Color fundus photograph · 45° field of view · 2048 by 1536 pixels
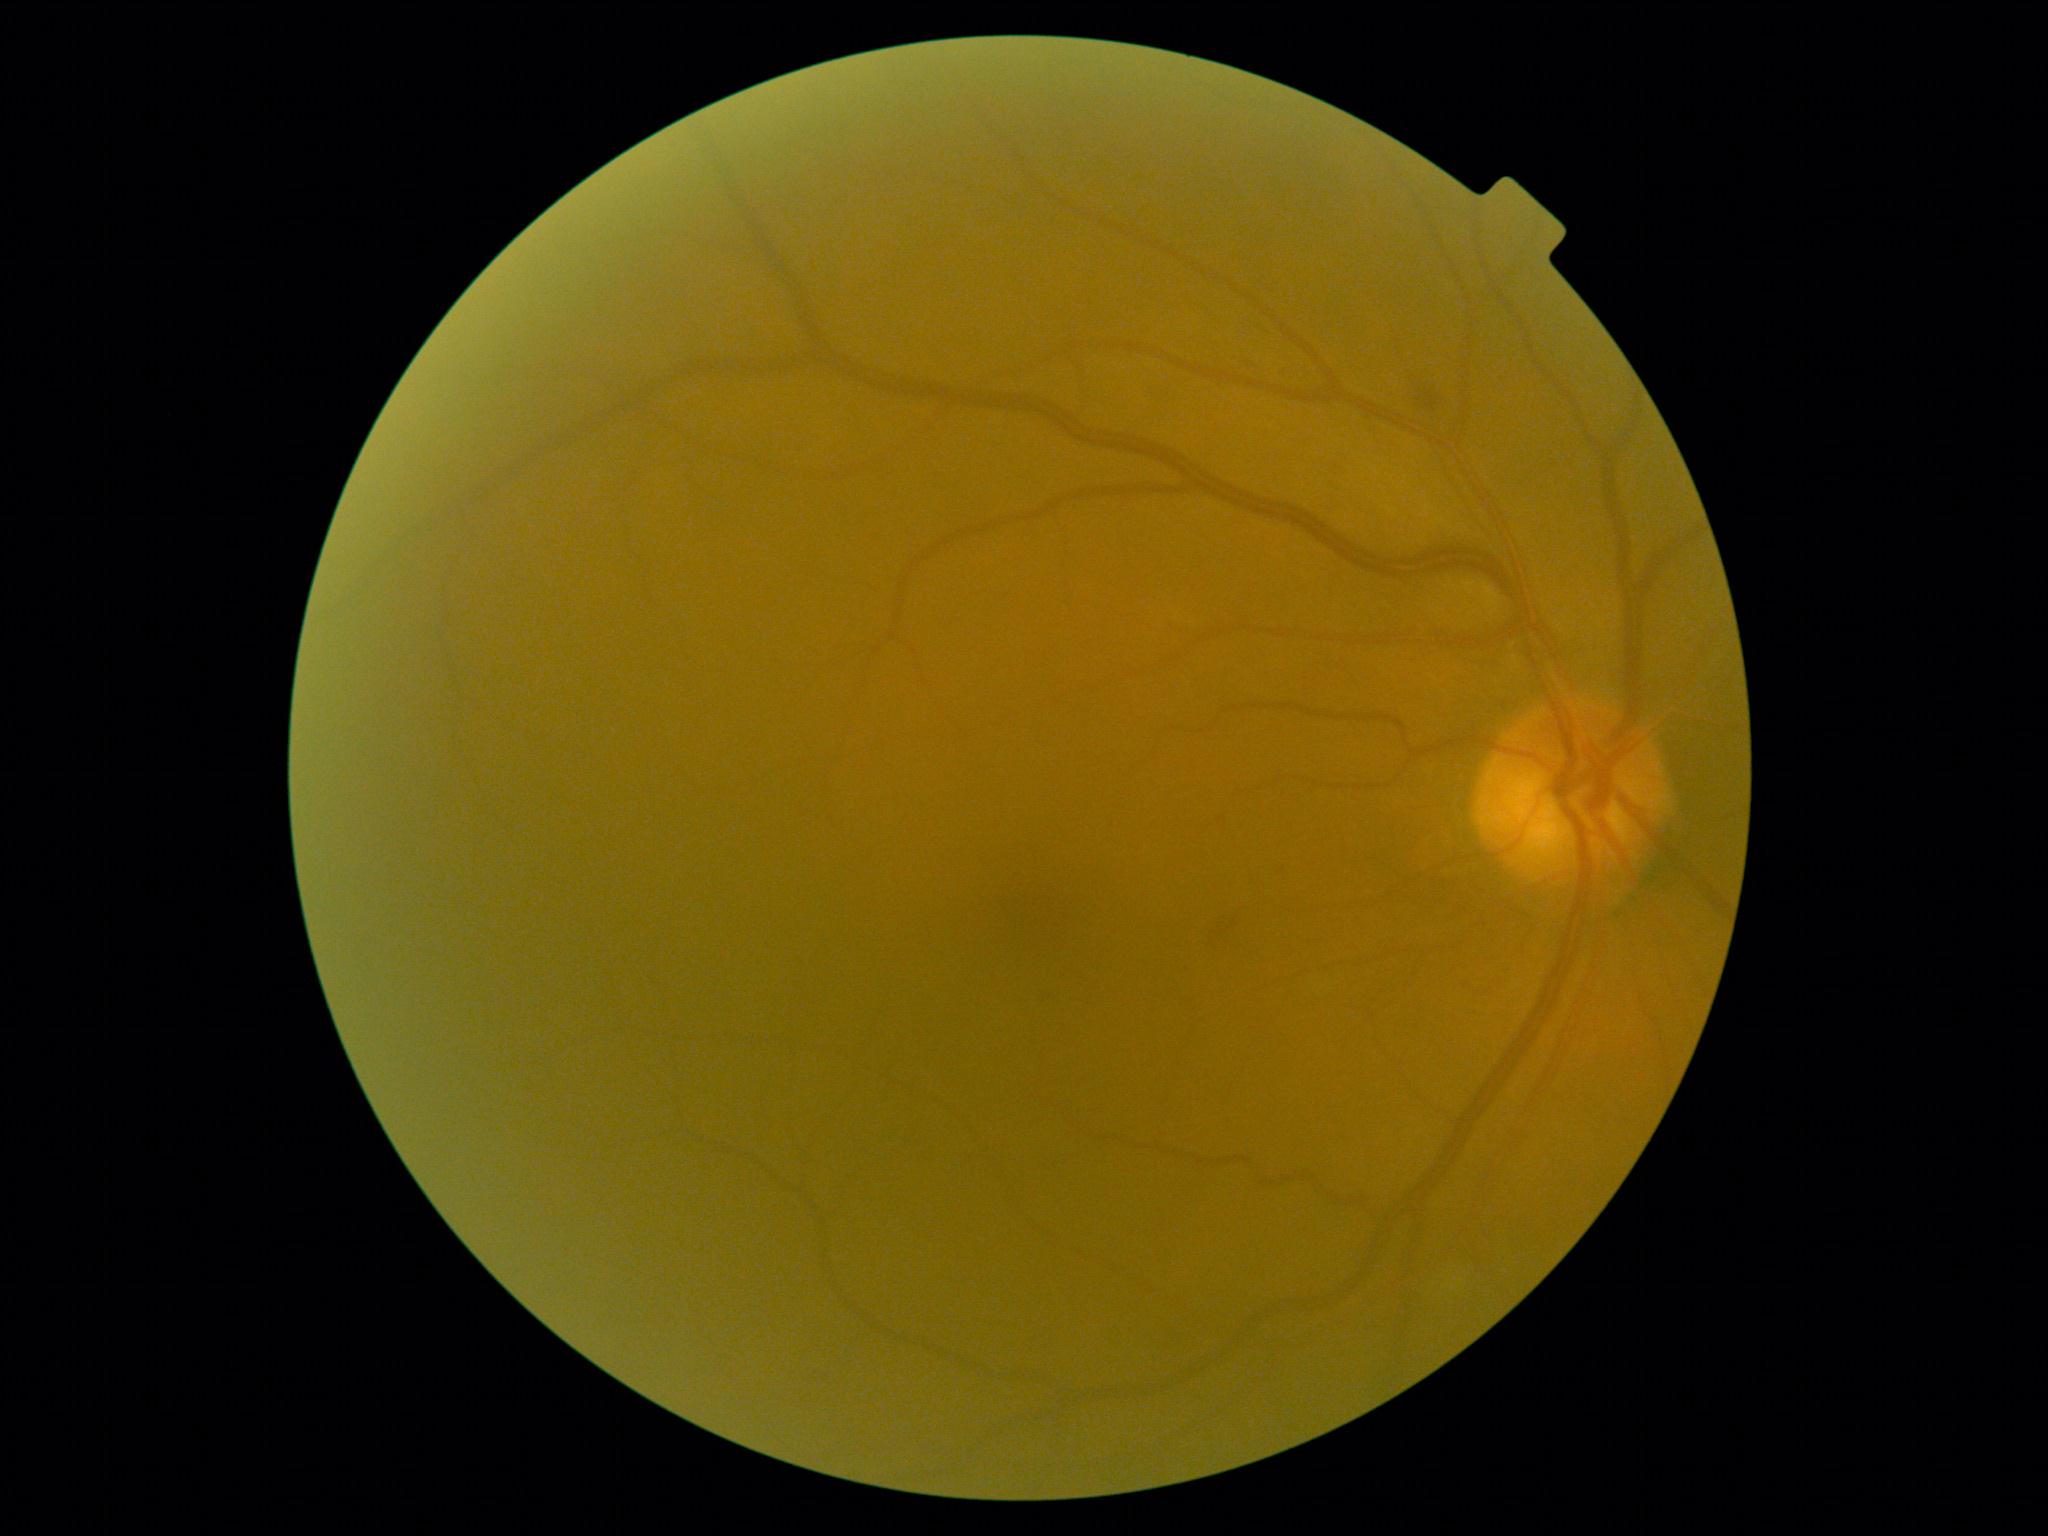 DR severity is grade 2 (moderate NPDR). The retinopathy is classified as non-proliferative diabetic retinopathy.